Corneal thickness 523 µm
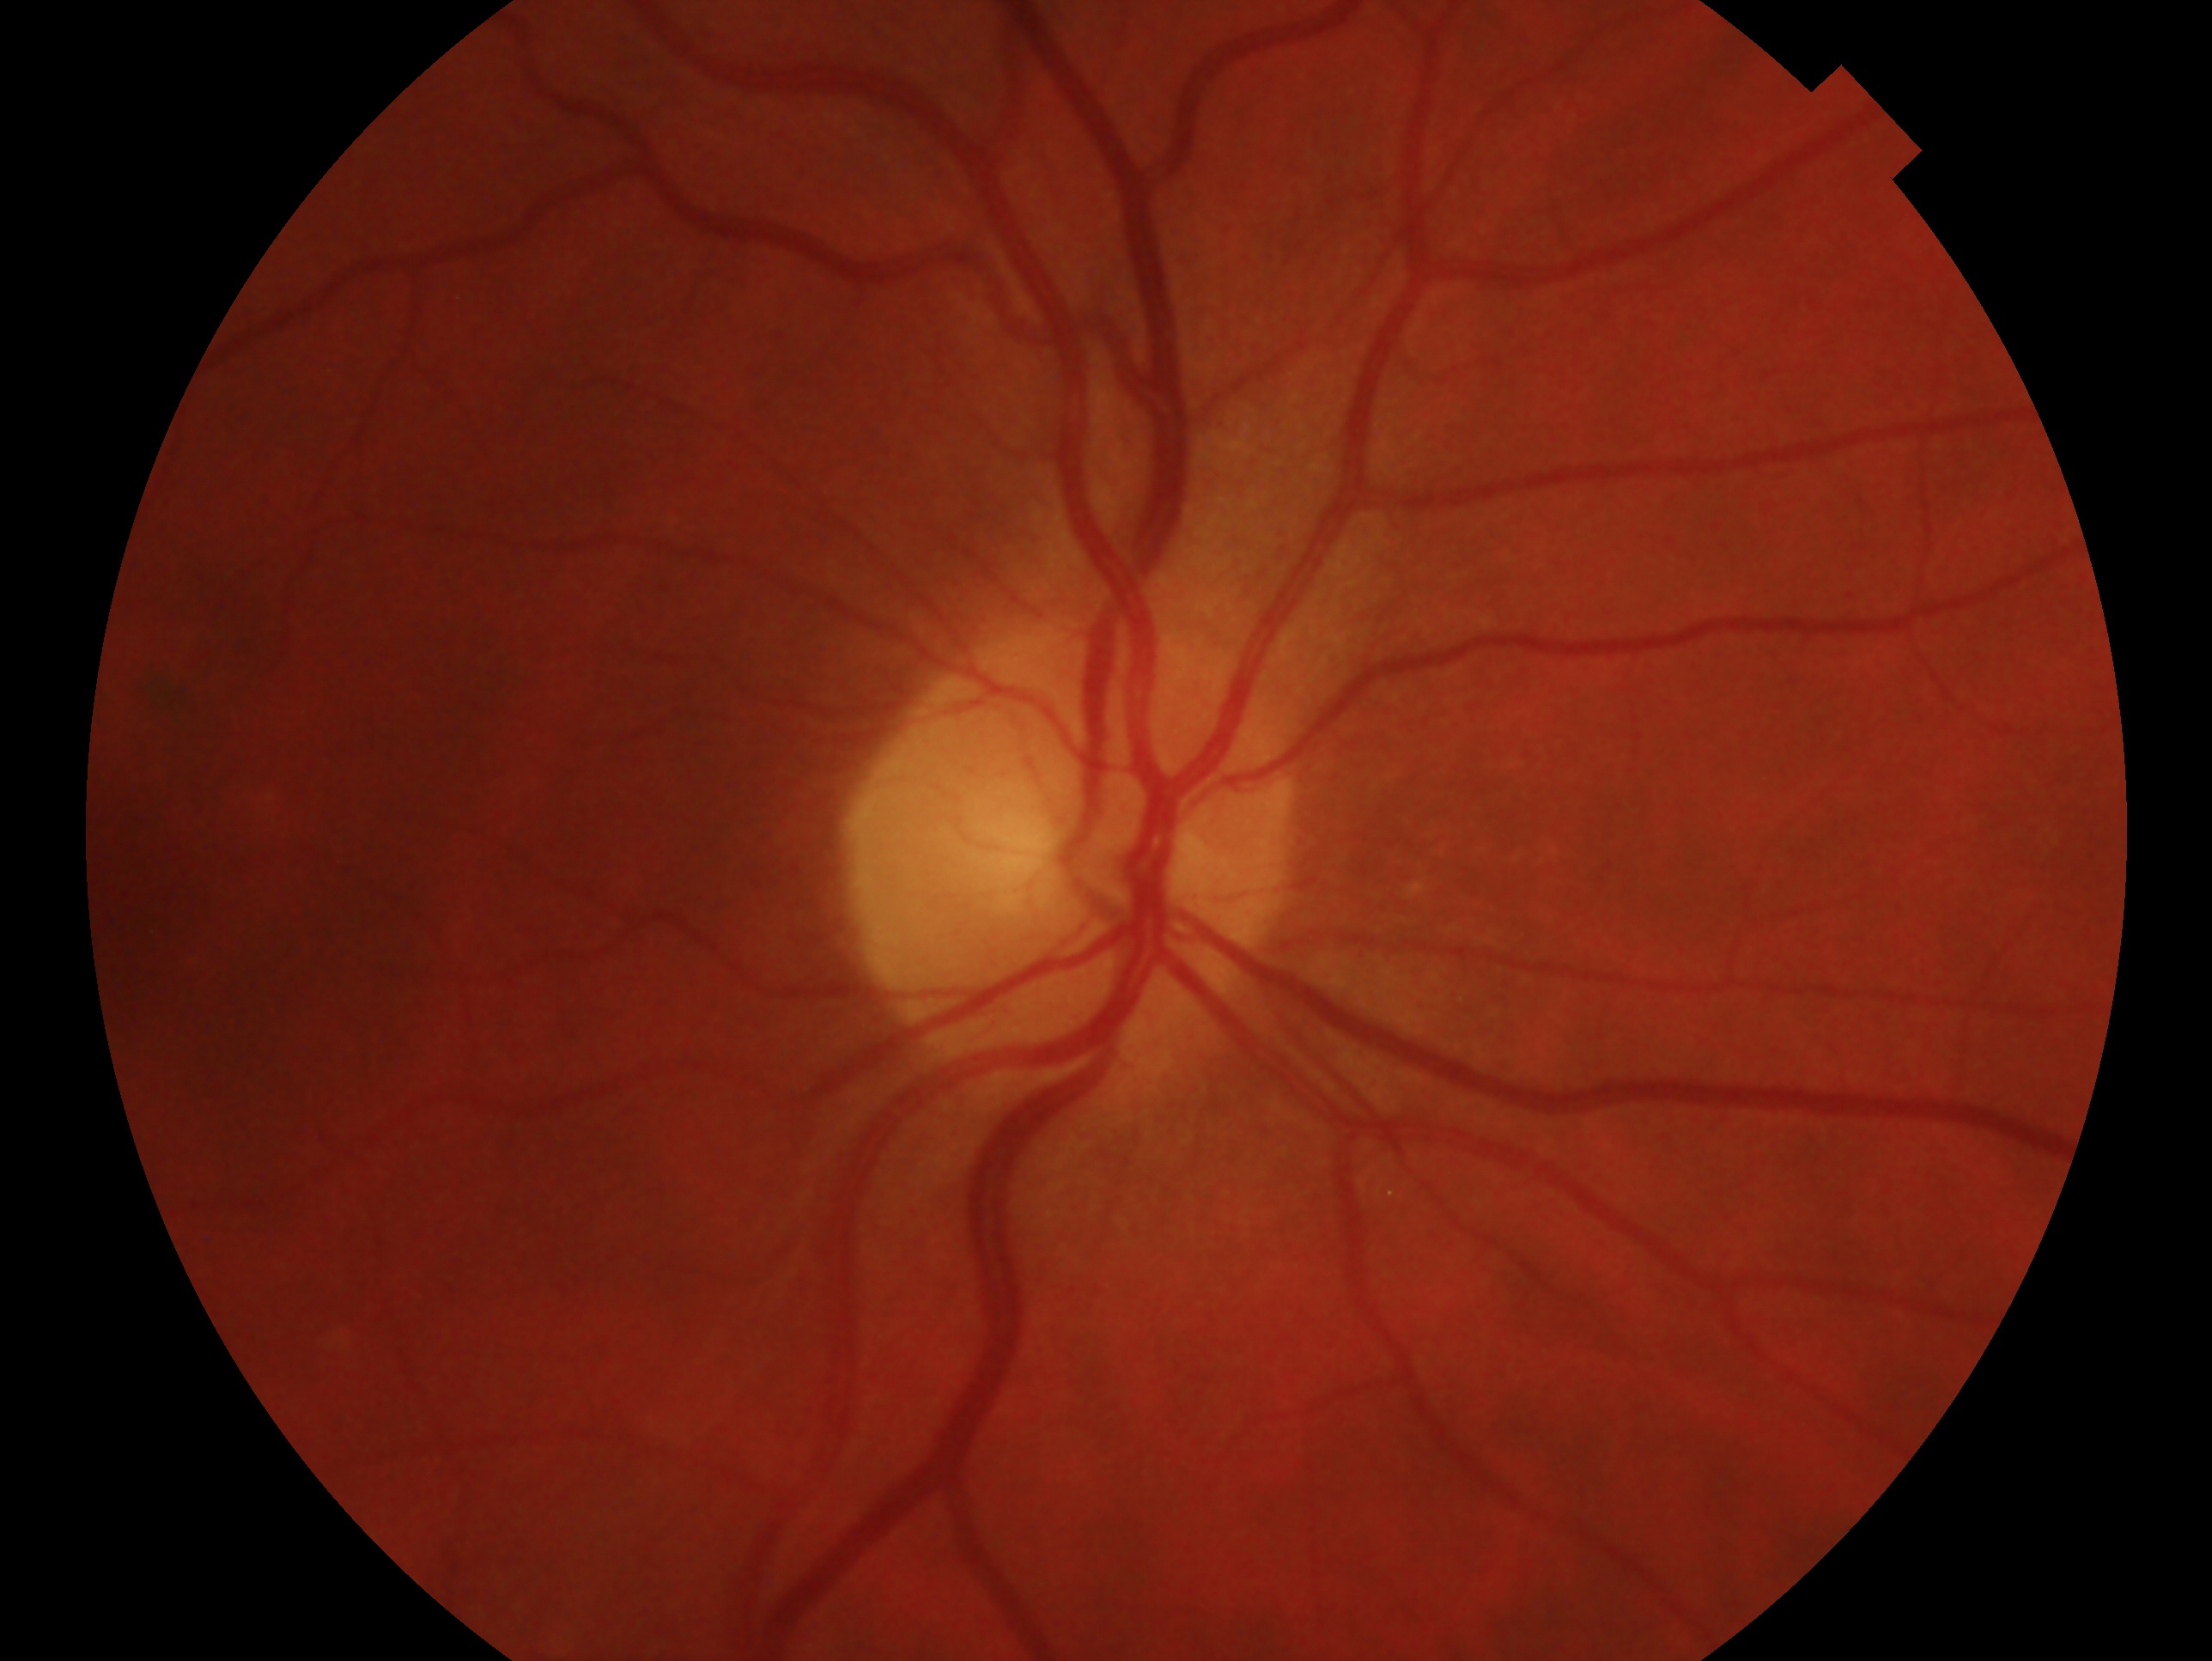

This is the oculus dexter. Glaucoma status: no glaucomatous findings.